CFP — 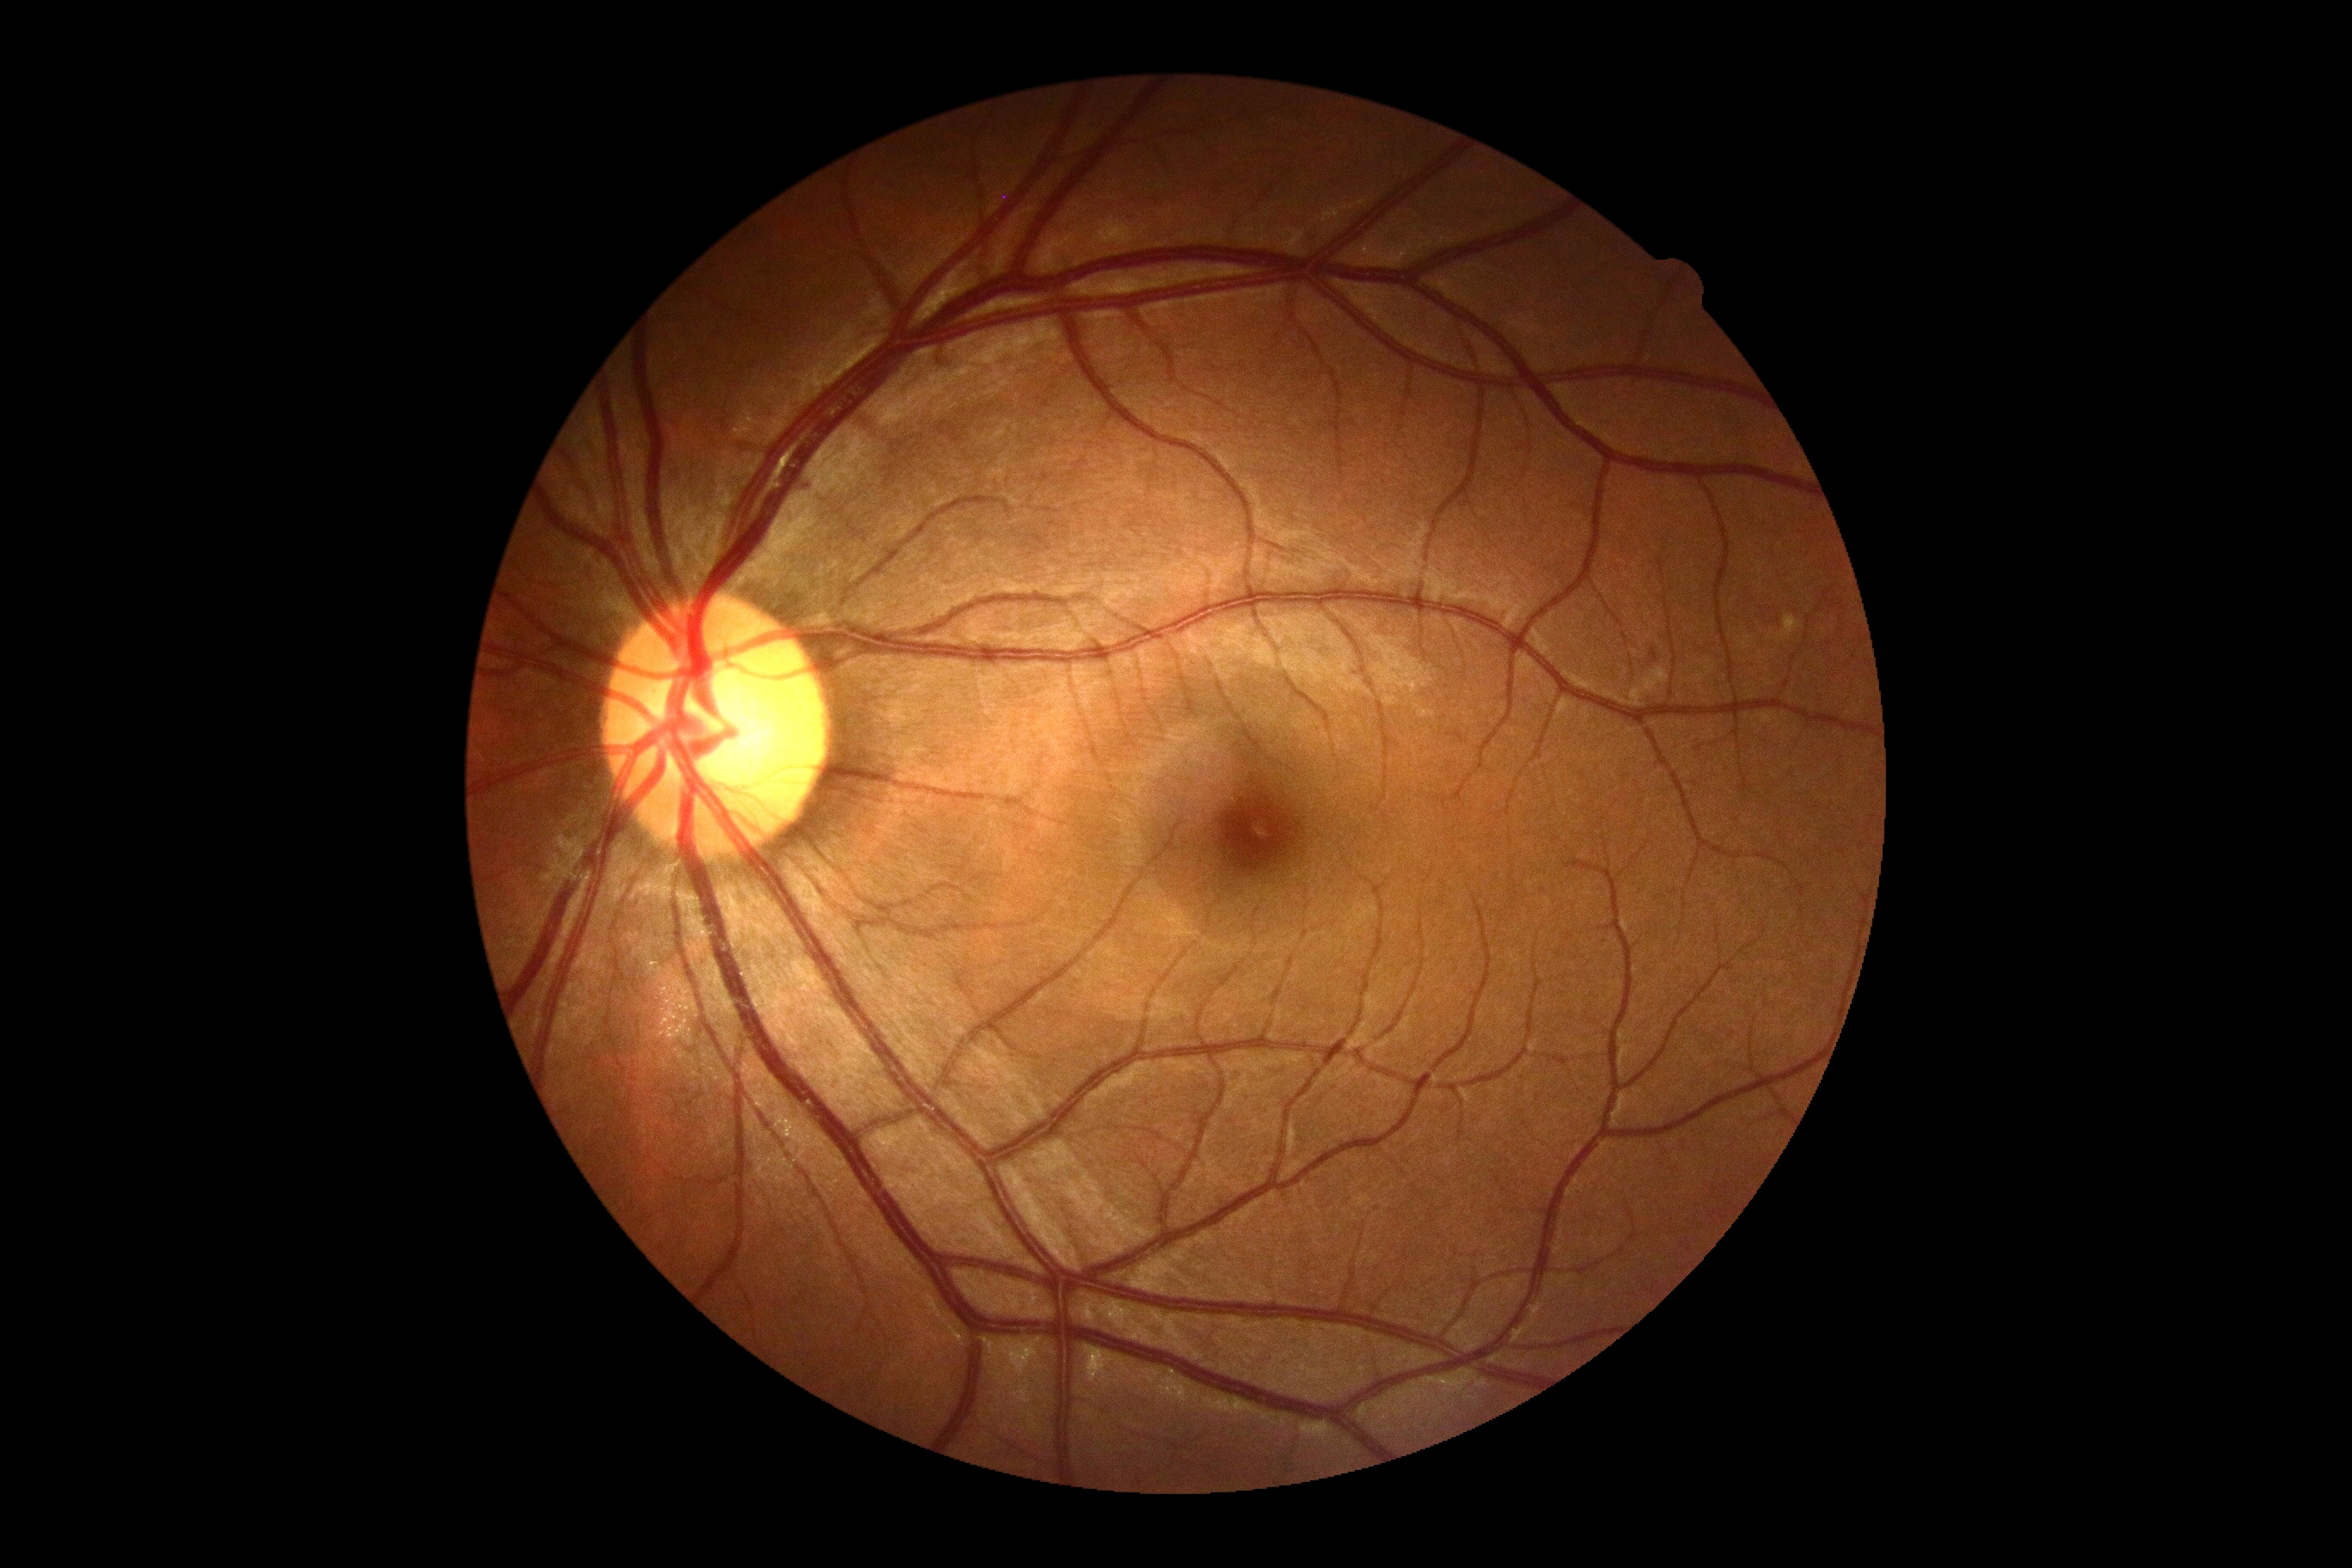
DR severity = no apparent diabetic retinopathy (grade 0) — no visible signs of diabetic retinopathy.